NIDEK AFC-230; modified Davis grading.
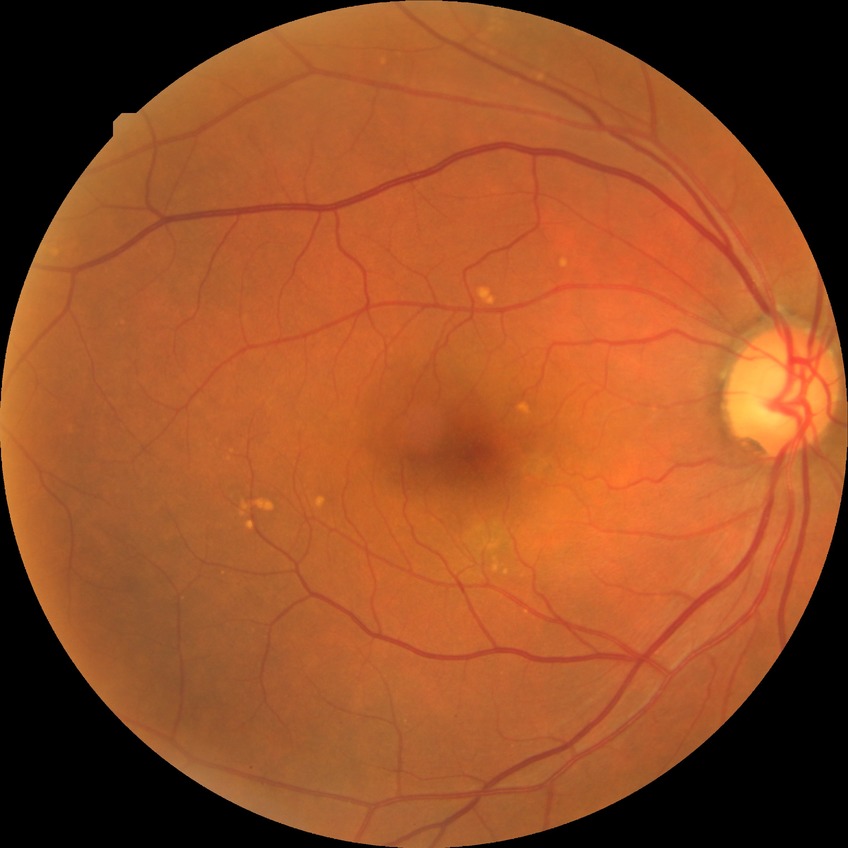 No signs of diabetic retinopathy.
DR grade is NDR.